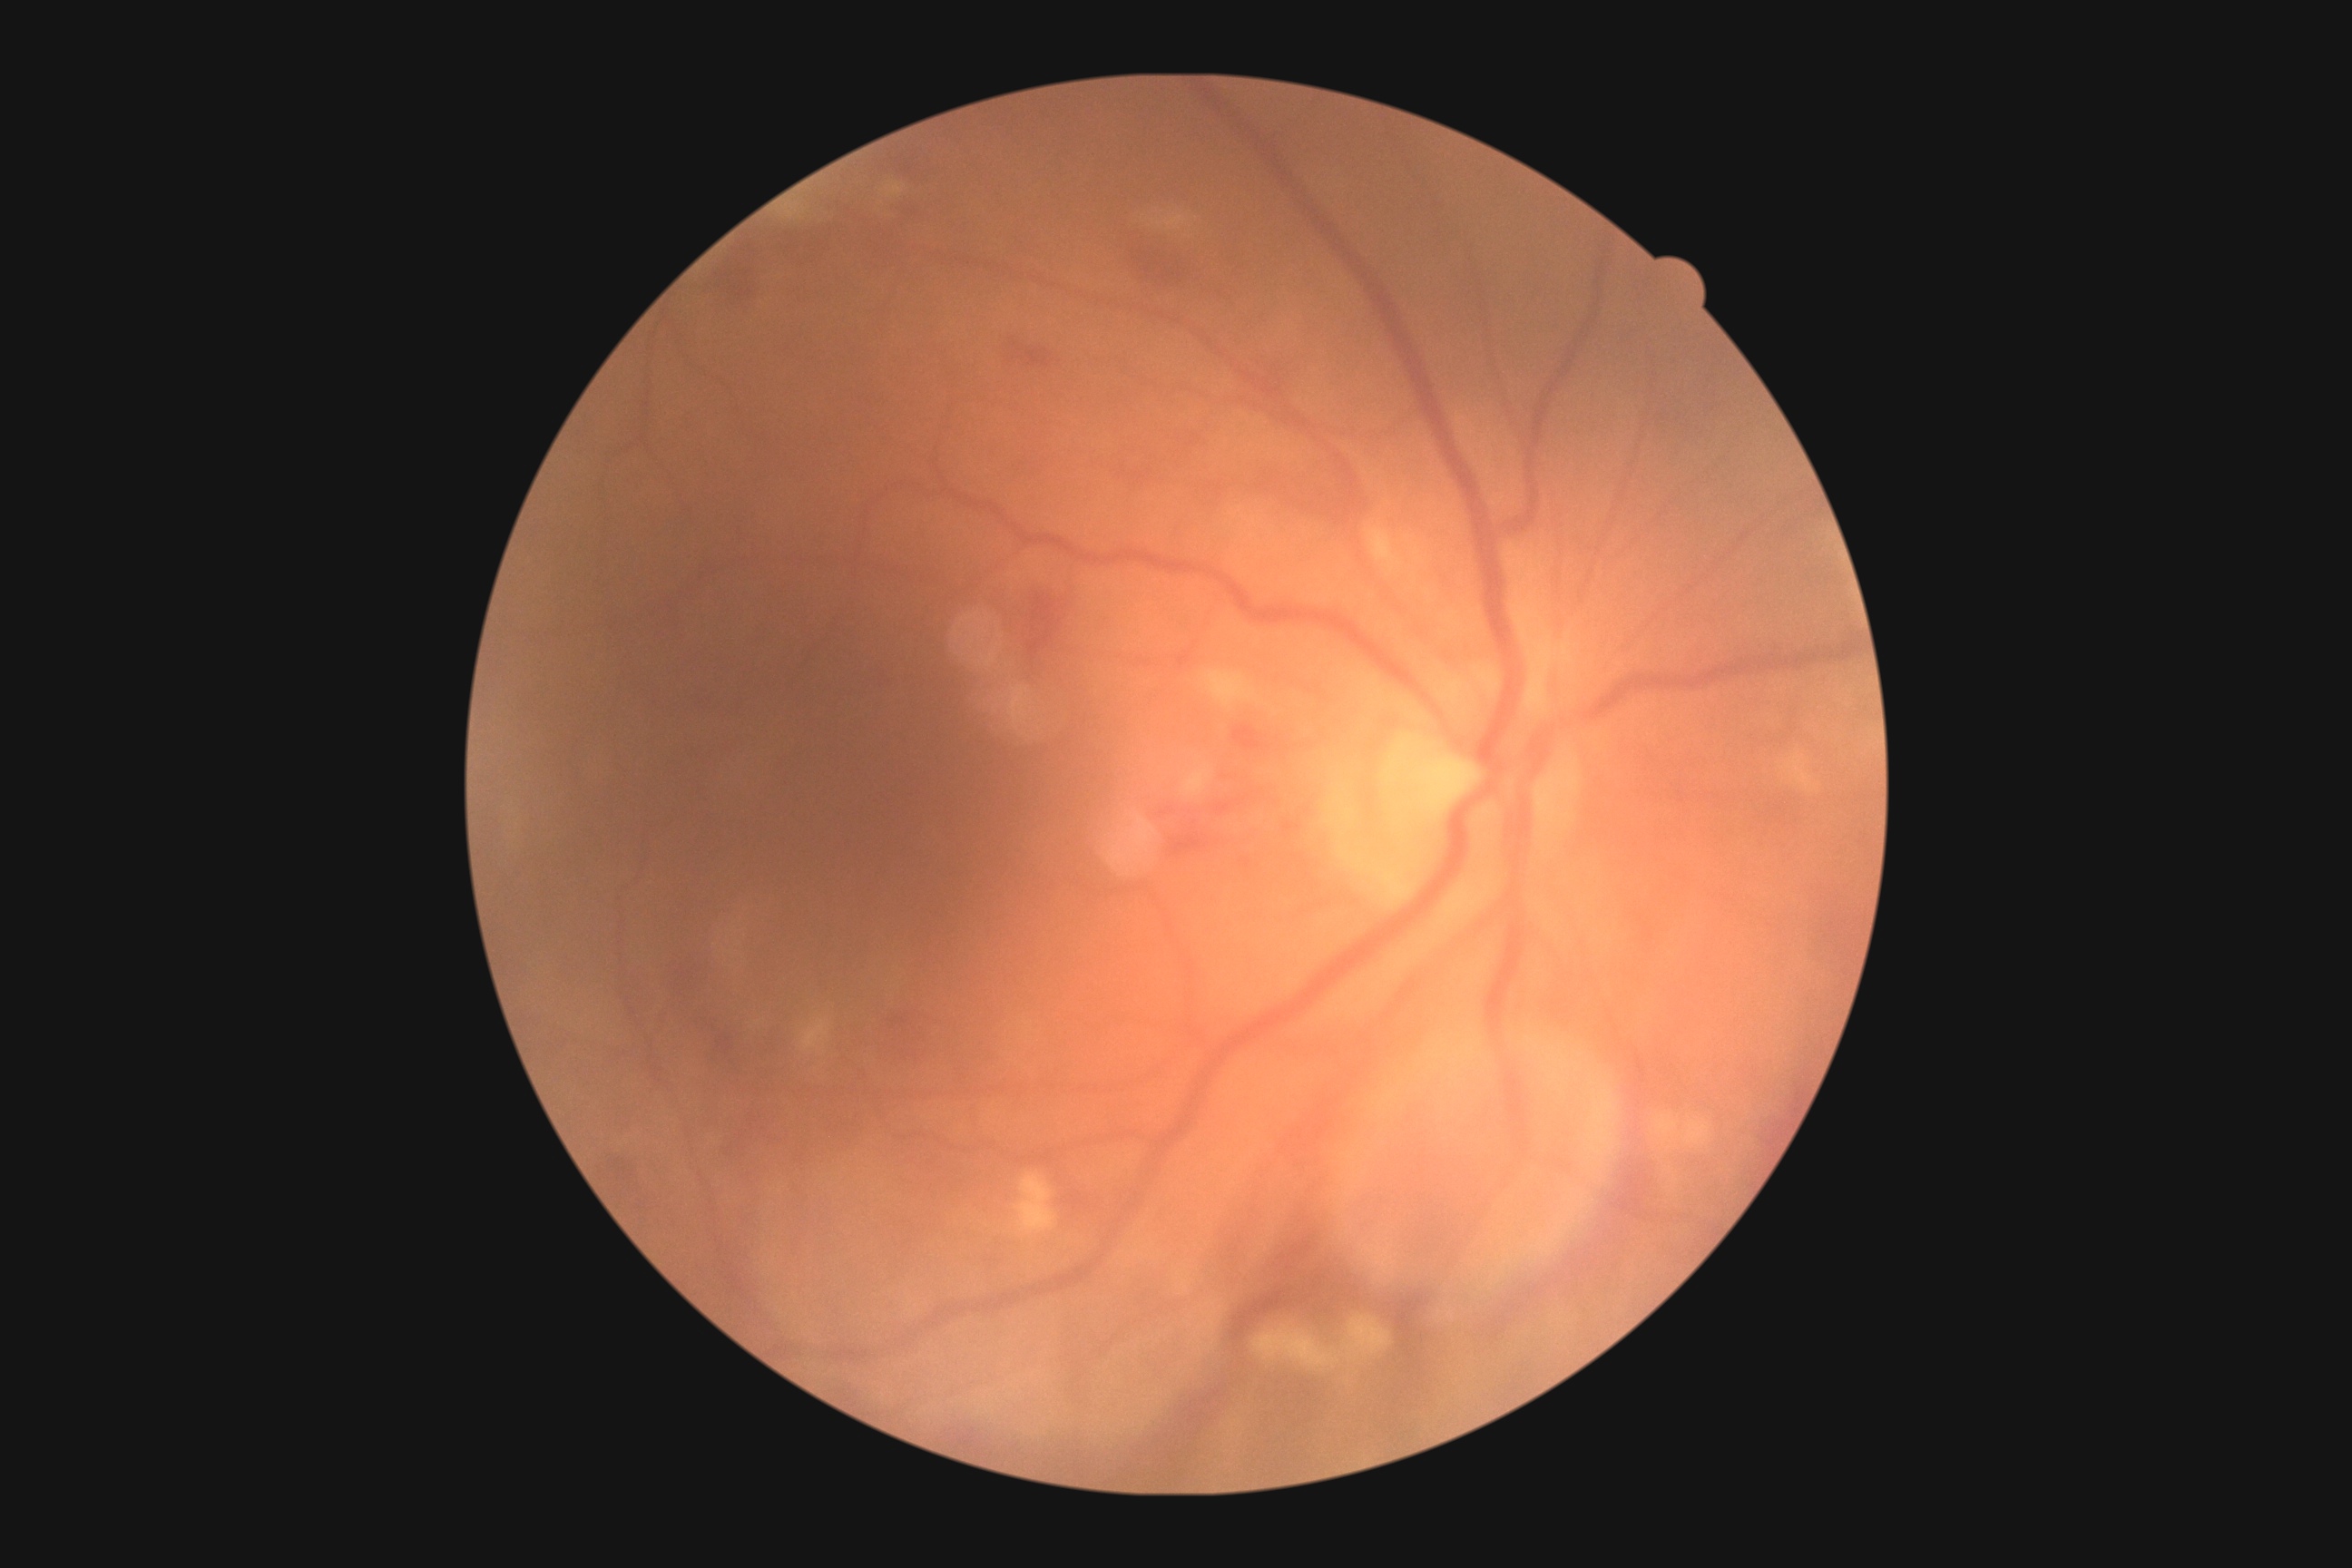

DR stage = grade 2 (moderate NPDR).